45° field of view.
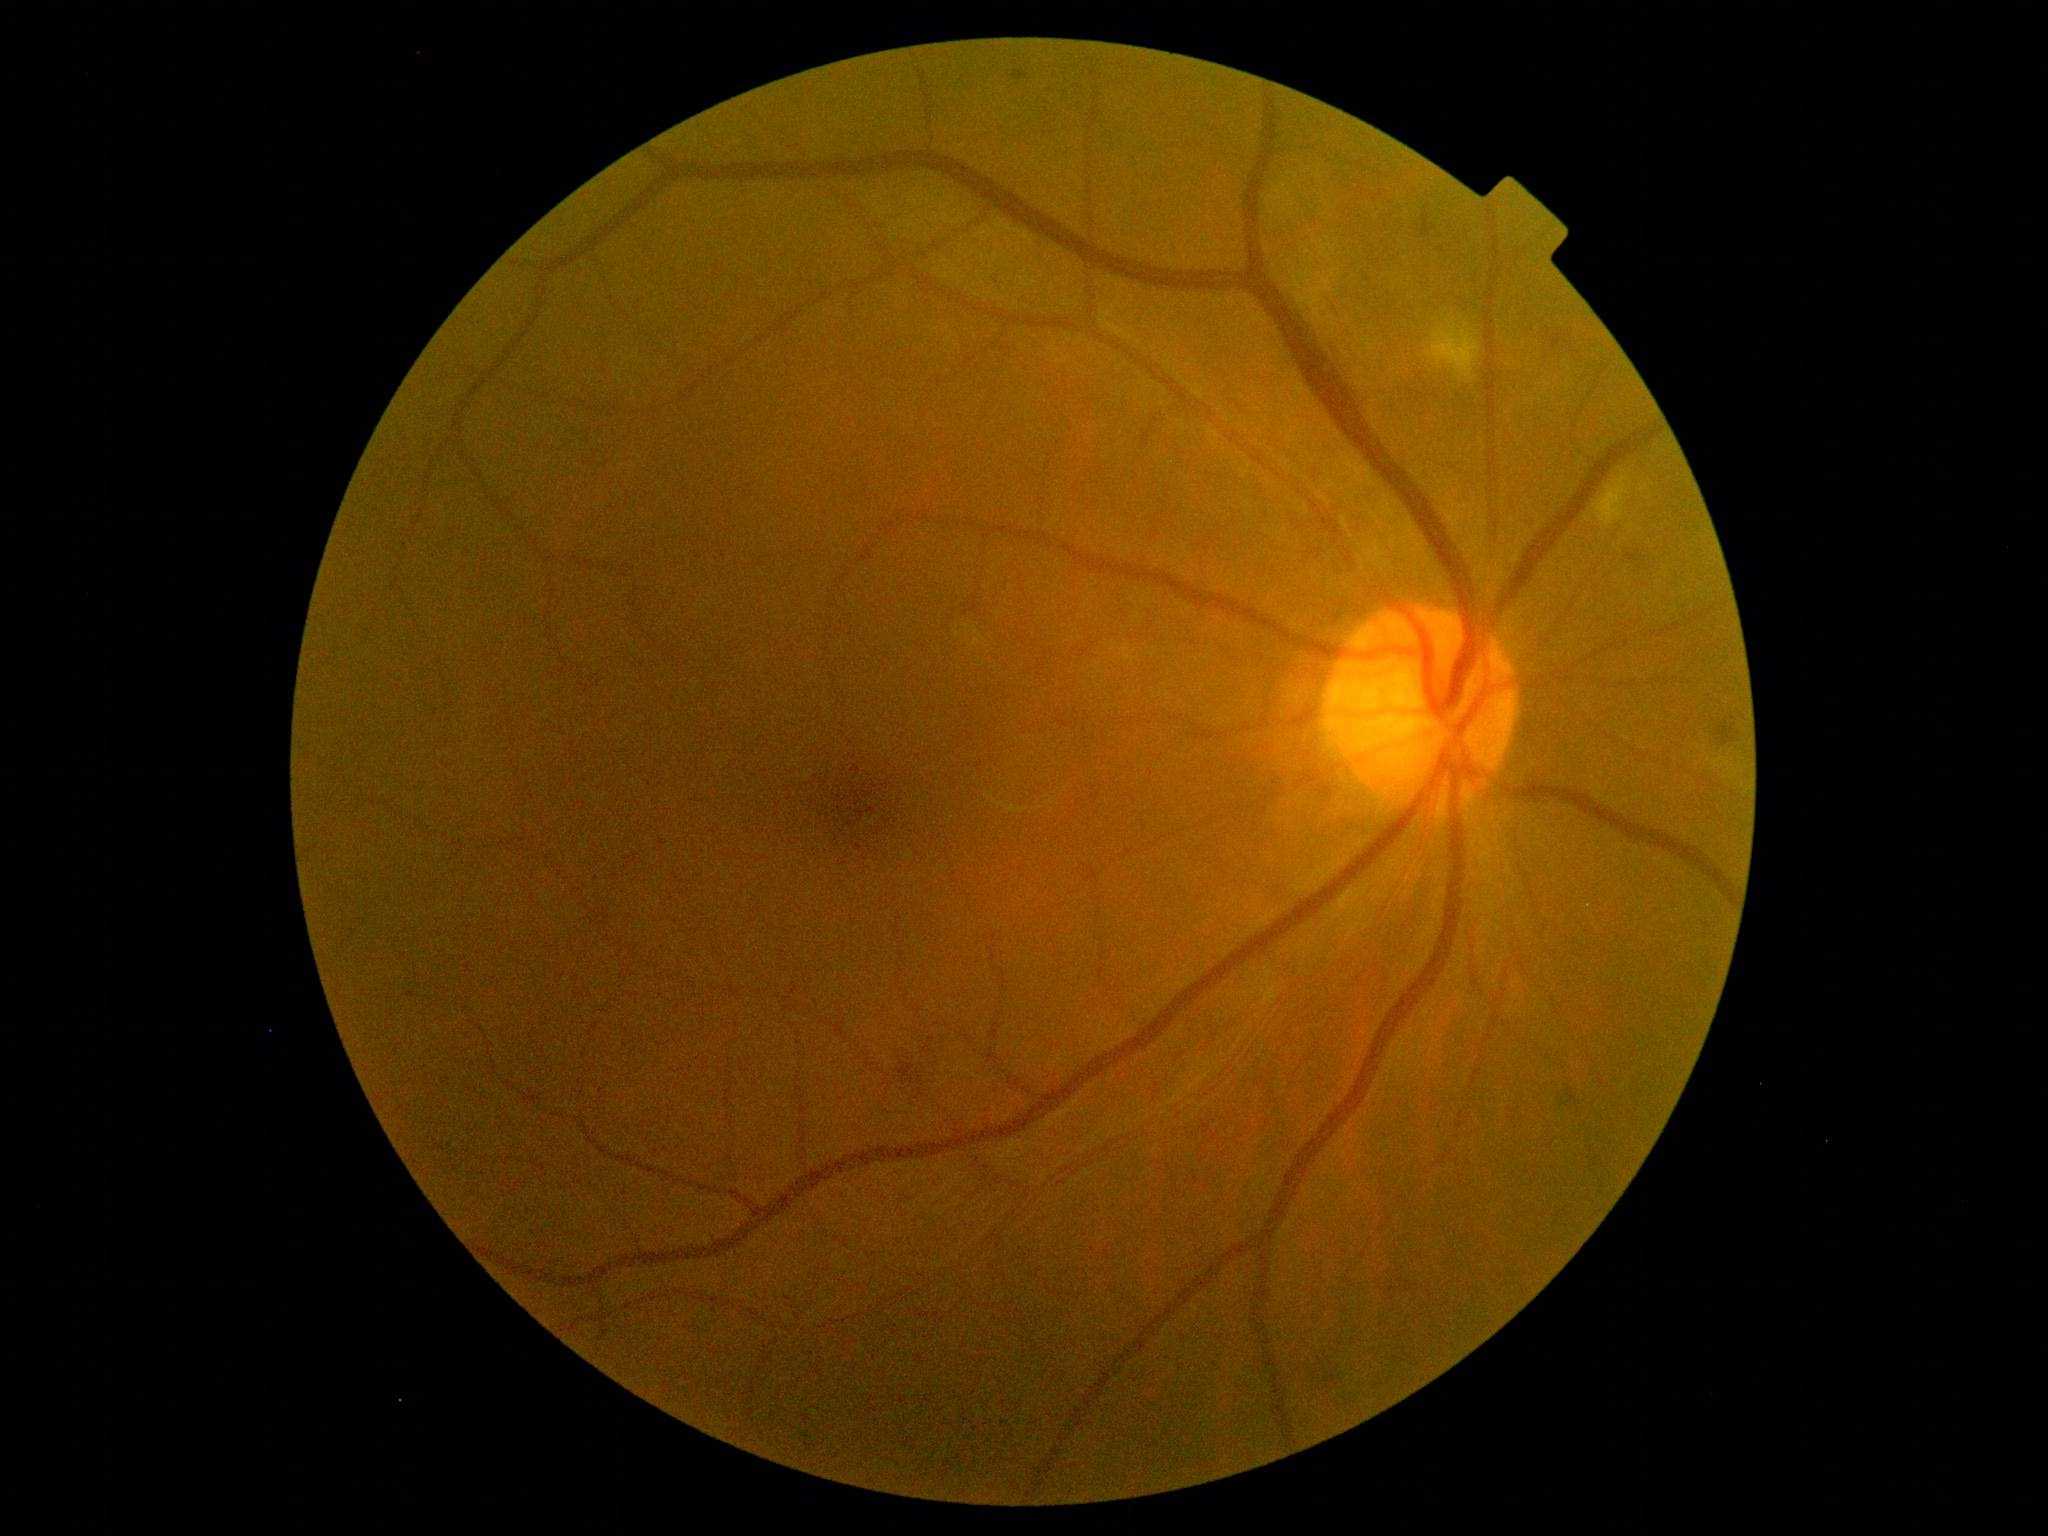
DR grade: moderate non-proliferative diabetic retinopathy (2).